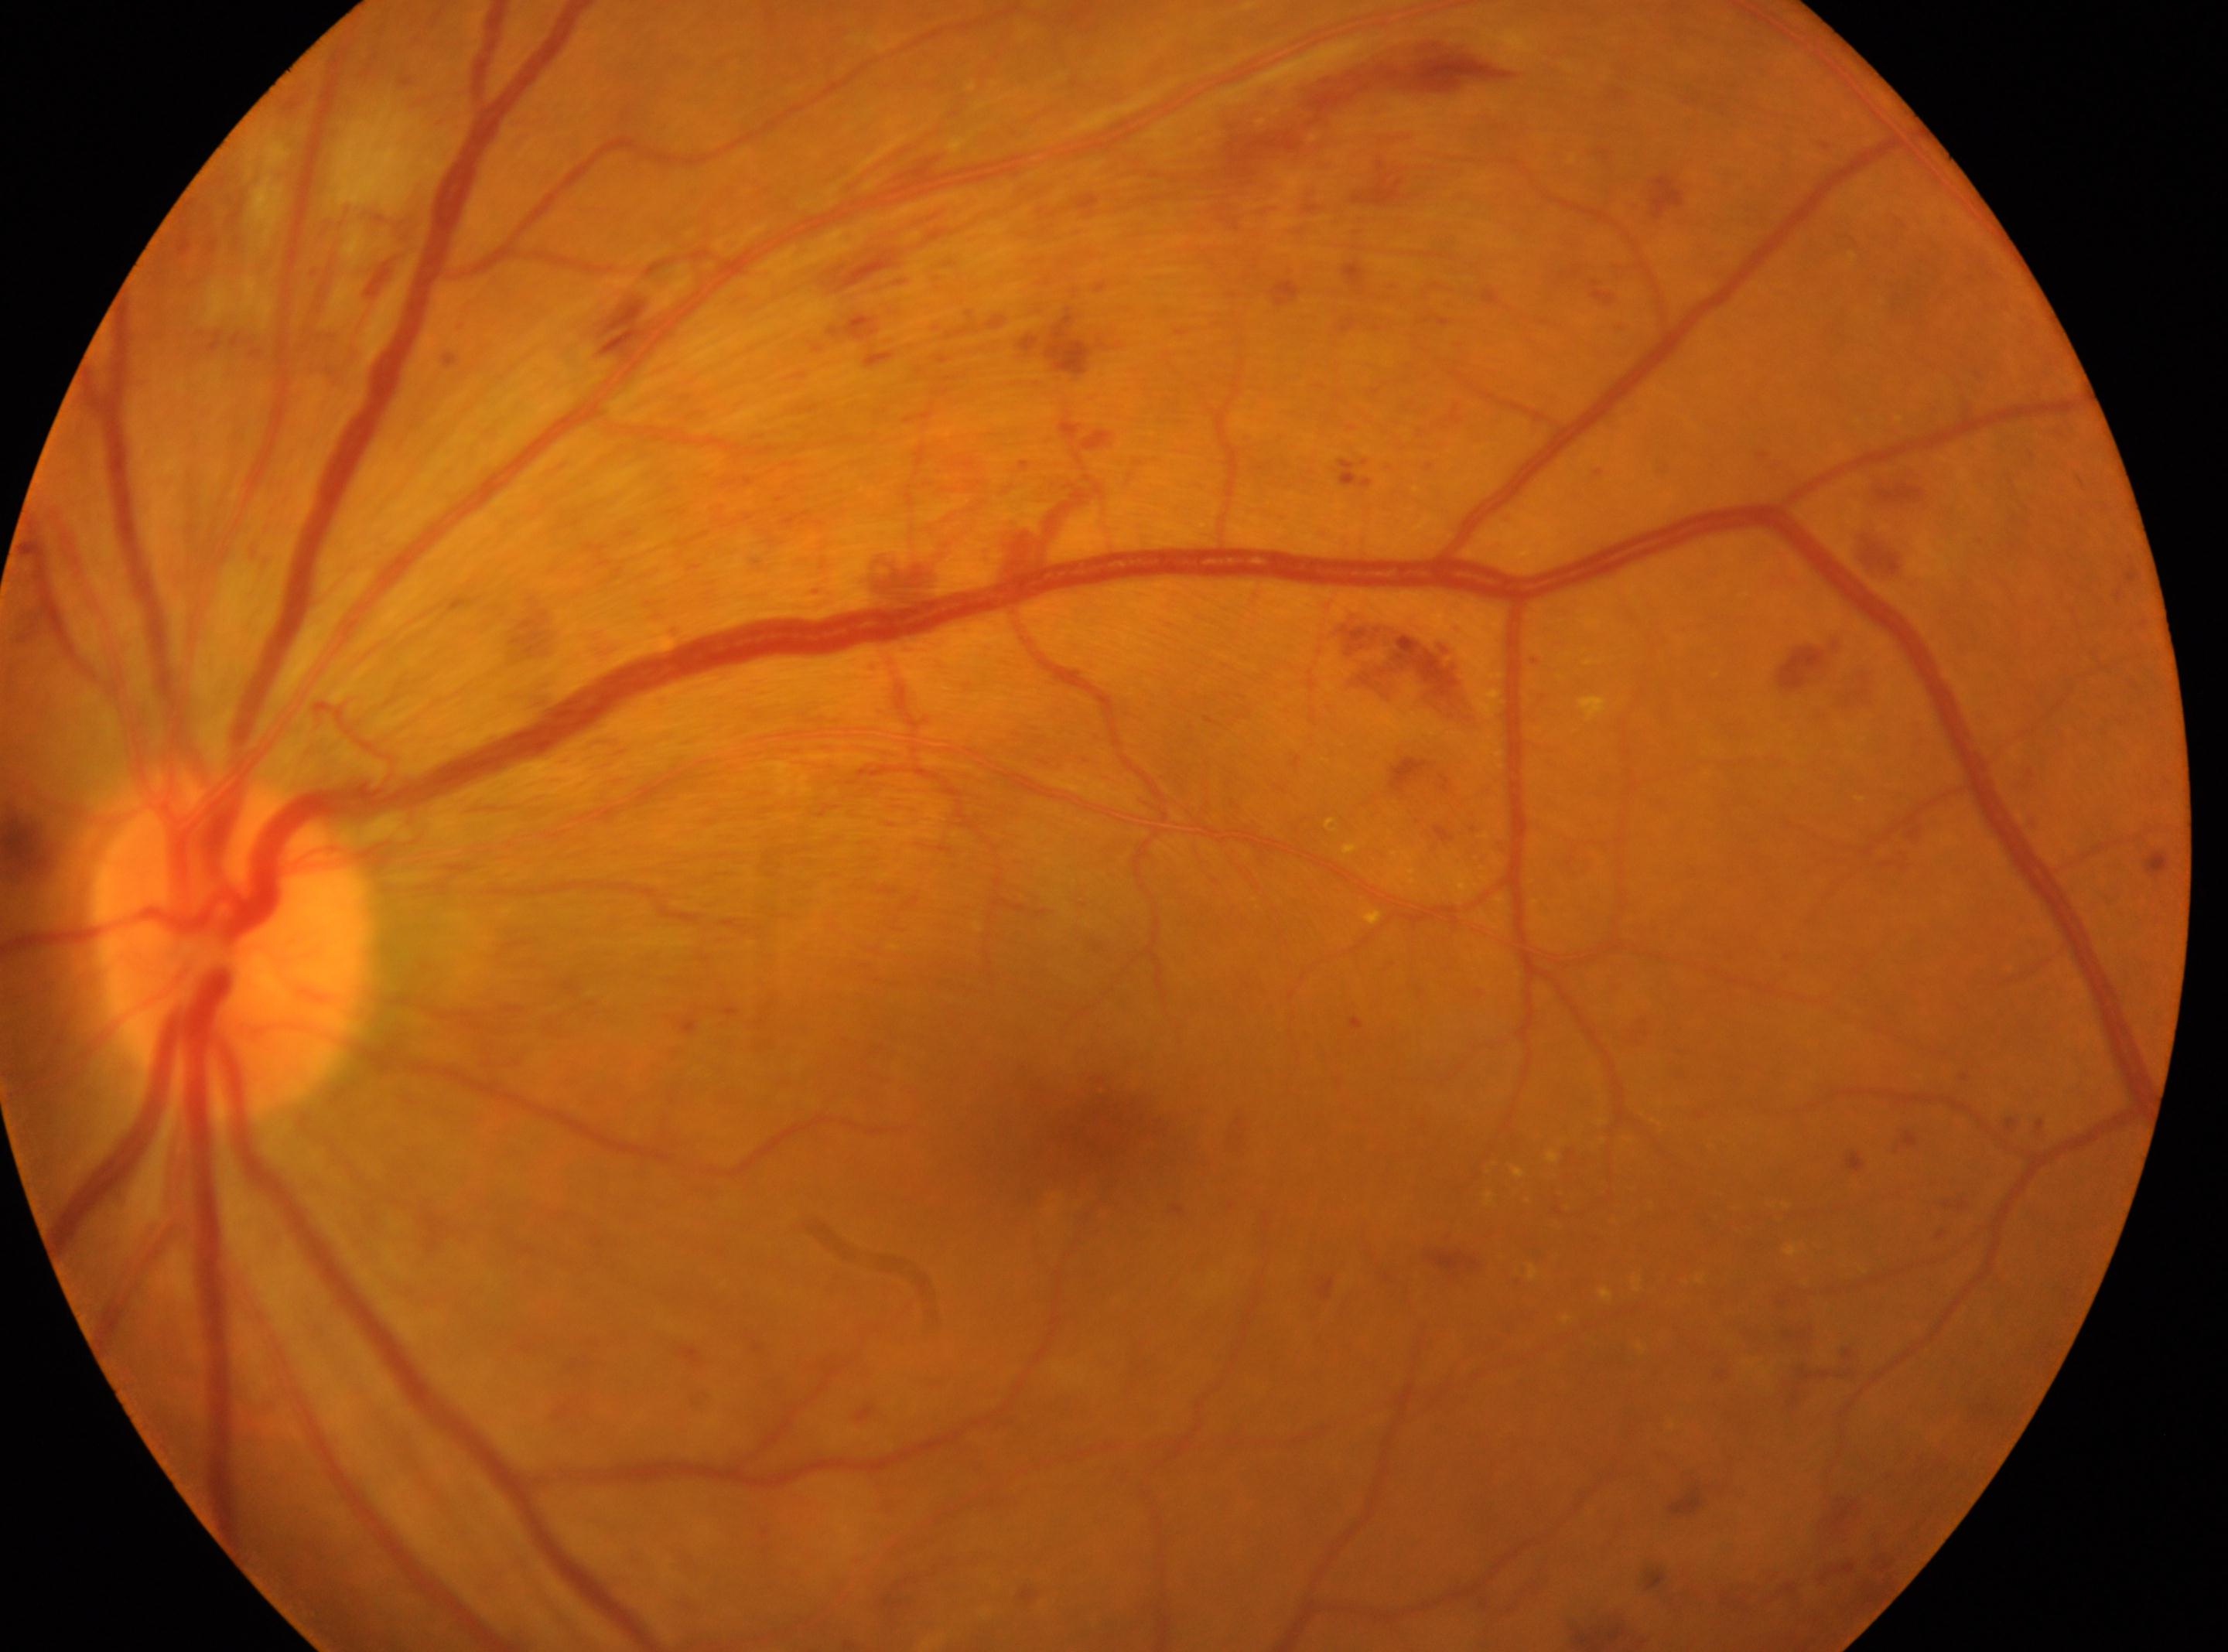 DR severity = severe non-proliferative diabetic retinopathy (grade 3) — more than 20 intraretinal hemorrhages in each of 4 quadrants, definite venous beading in 2 or more quadrants, or prominent intraretinal microvascular abnormalities in 1 or more quadrants, with no signs of proliferative retinopathy | the fovea = 1108, 1132 | ONH = 233, 947 | laterality = left.